2089x1764px.
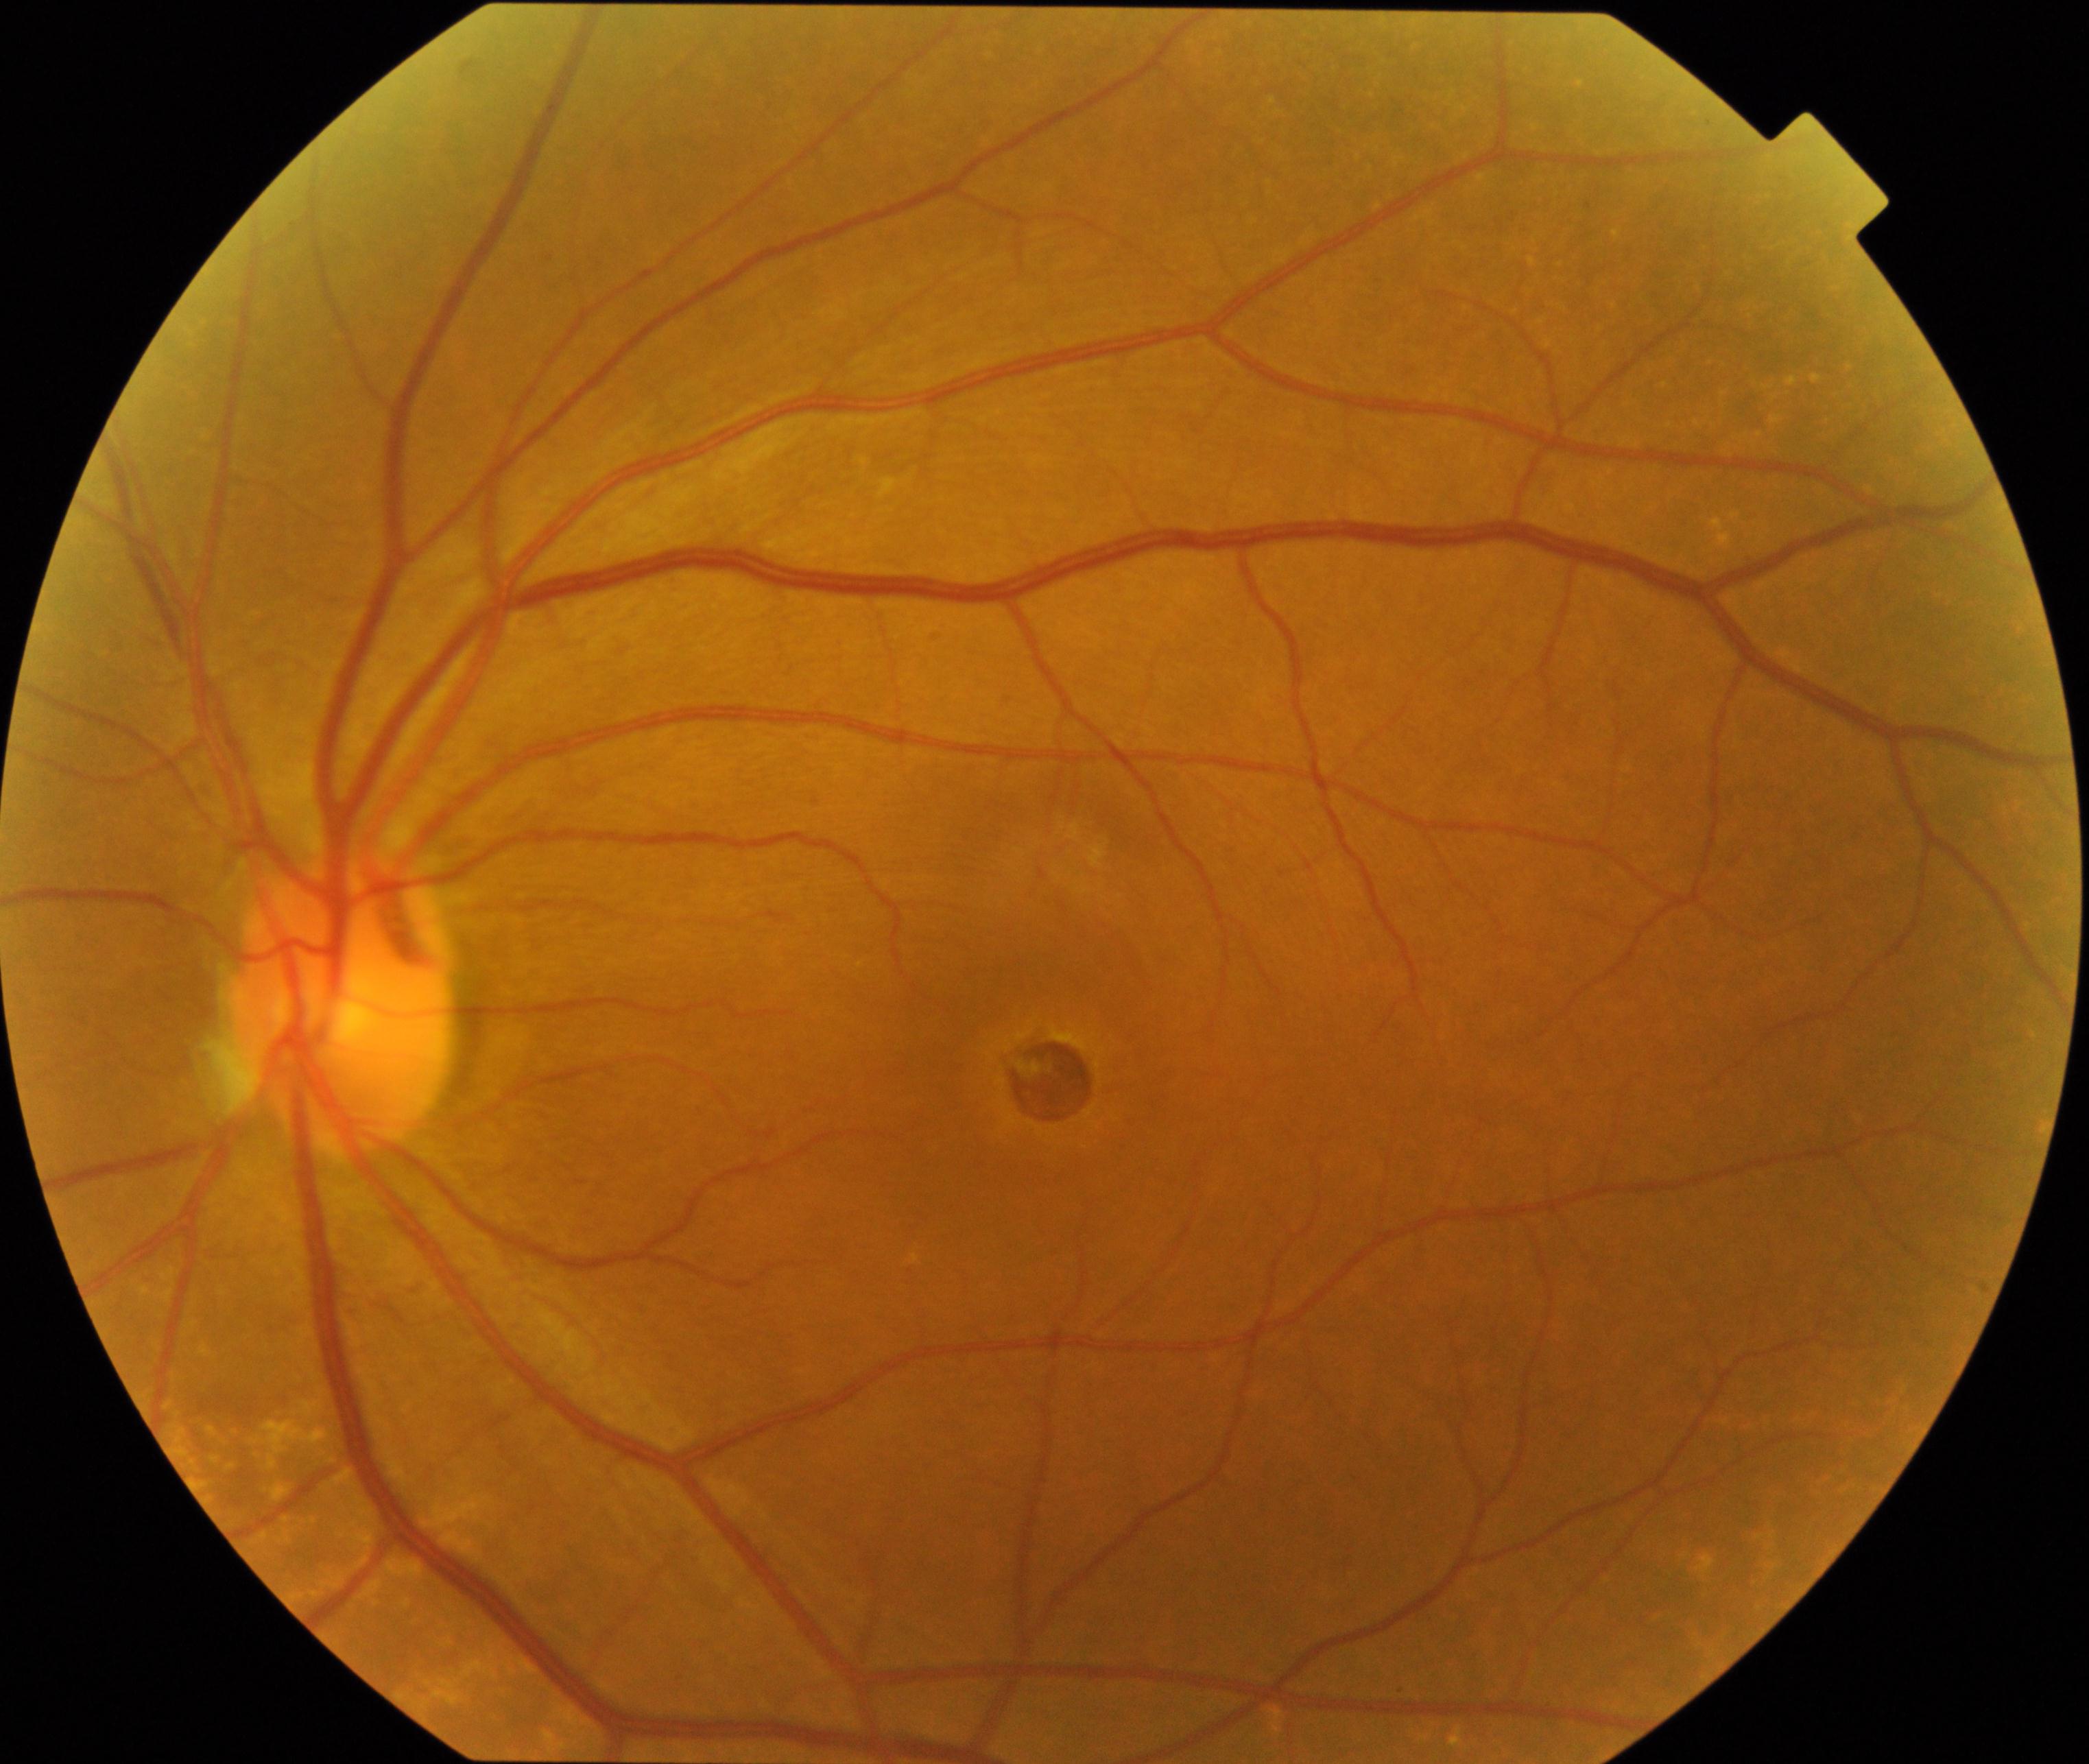
Appearance consistent with macular hole.